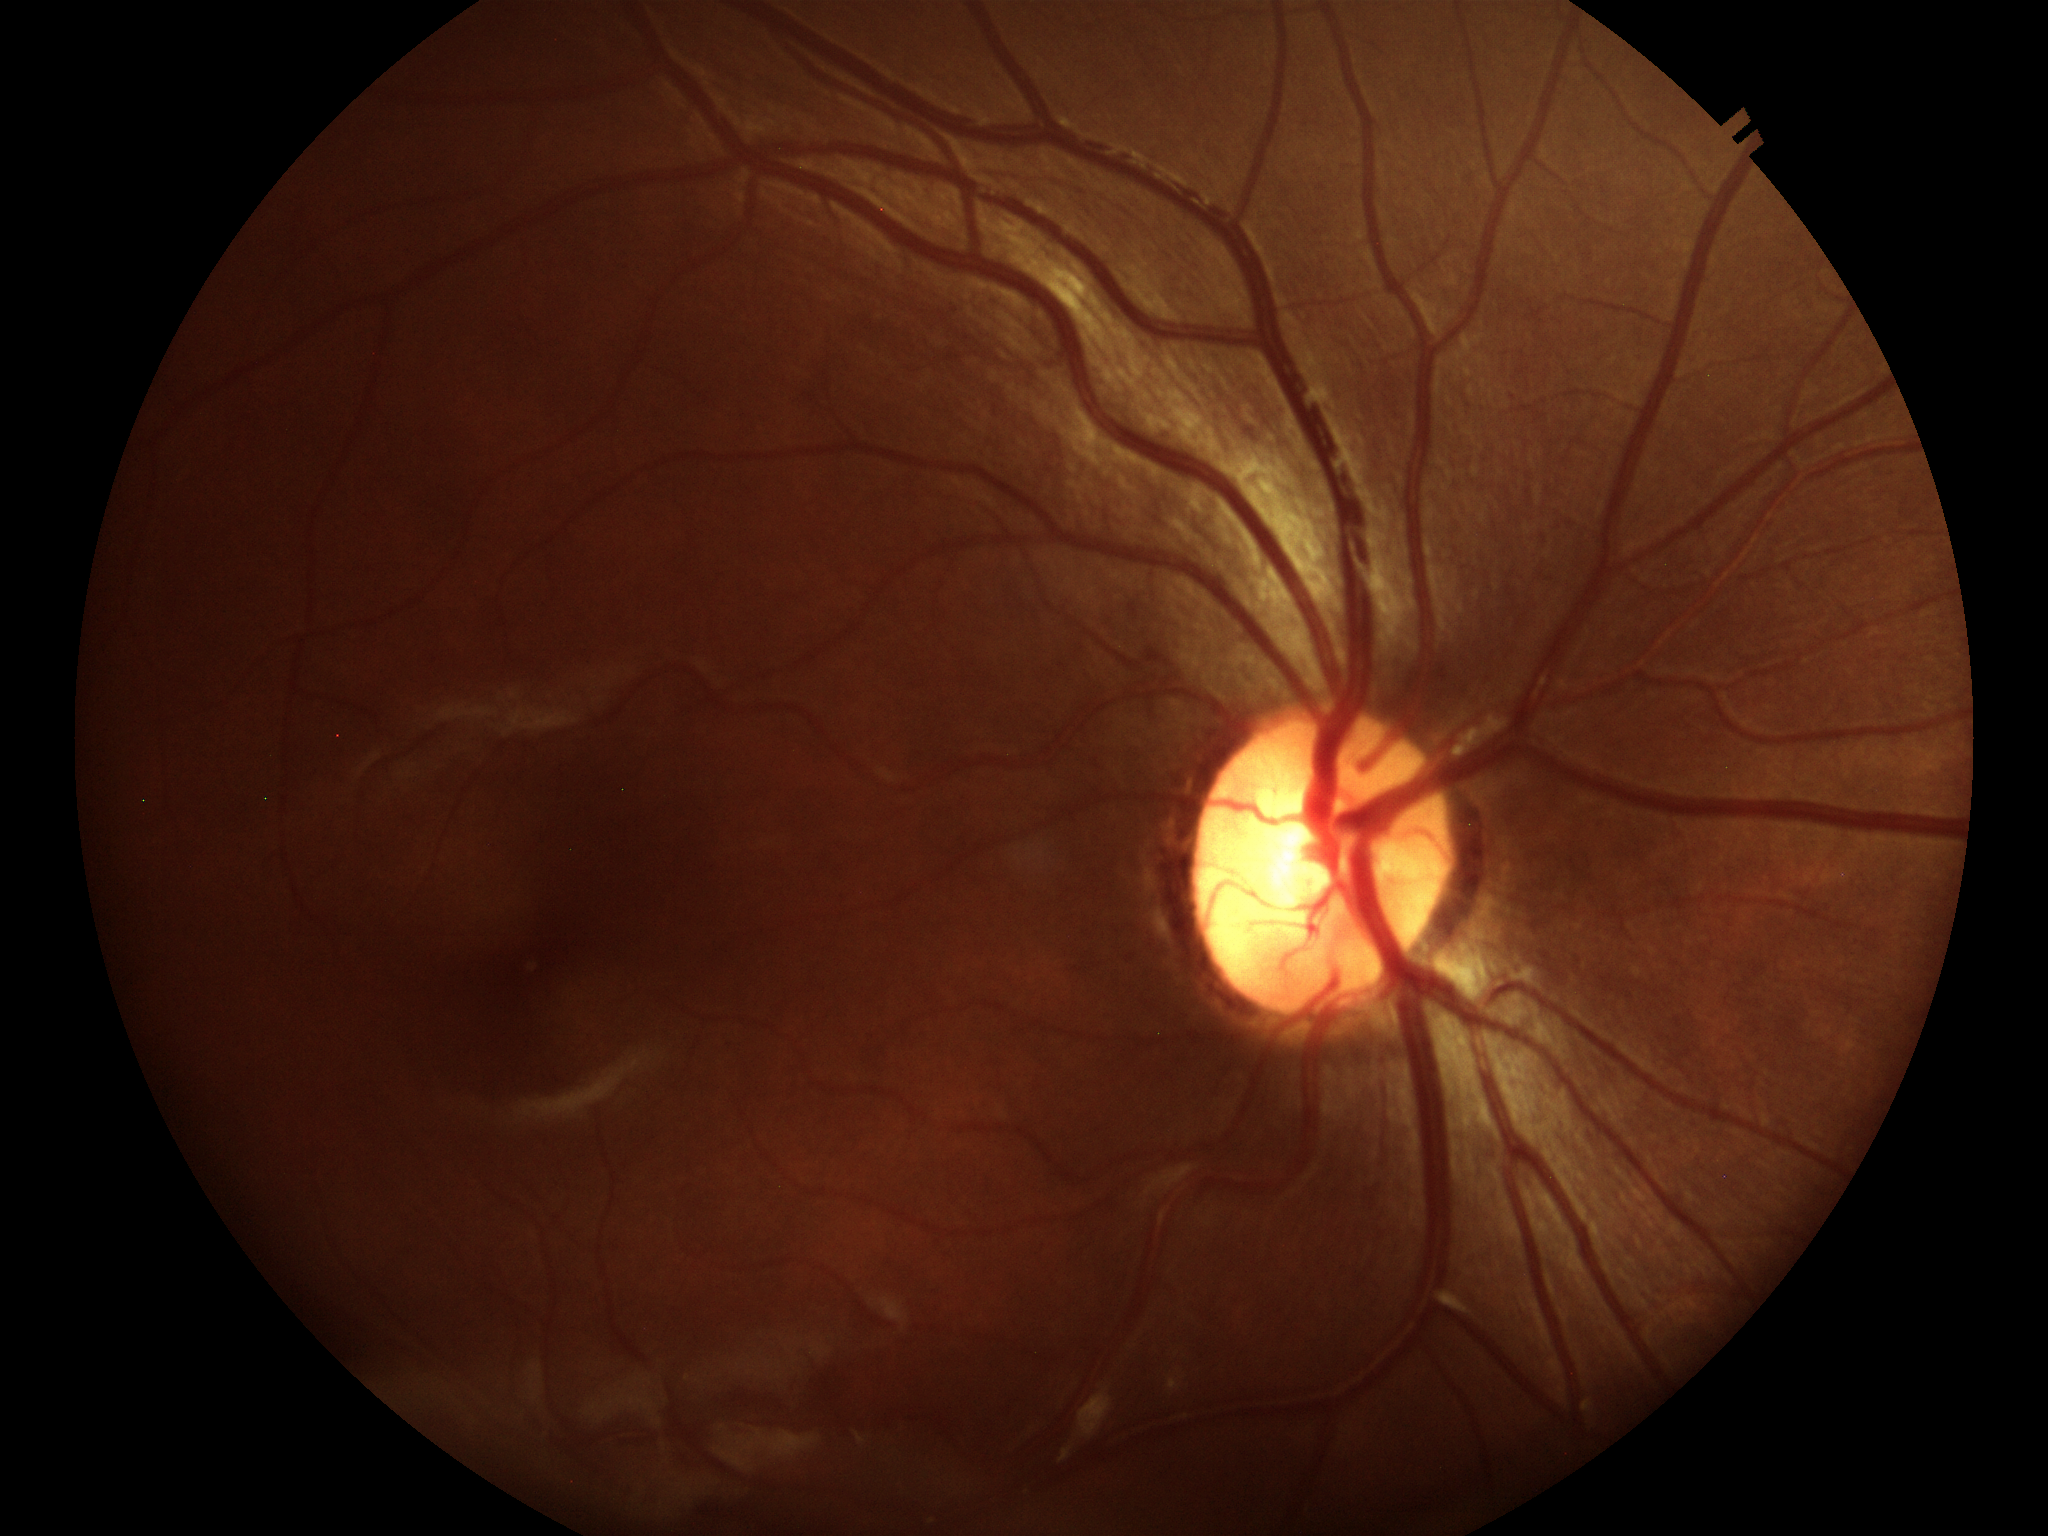

Not suspicious for glaucoma. Vertical C/D ratio of 0.53. Horizontal cup-to-disc ratio of 0.54. Area cup-disc ratio of 0.27.